Without pupil dilation · 848 x 848 pixels · 45 degree fundus photograph · NIDEK AFC-230 fundus camera · fundus photo: 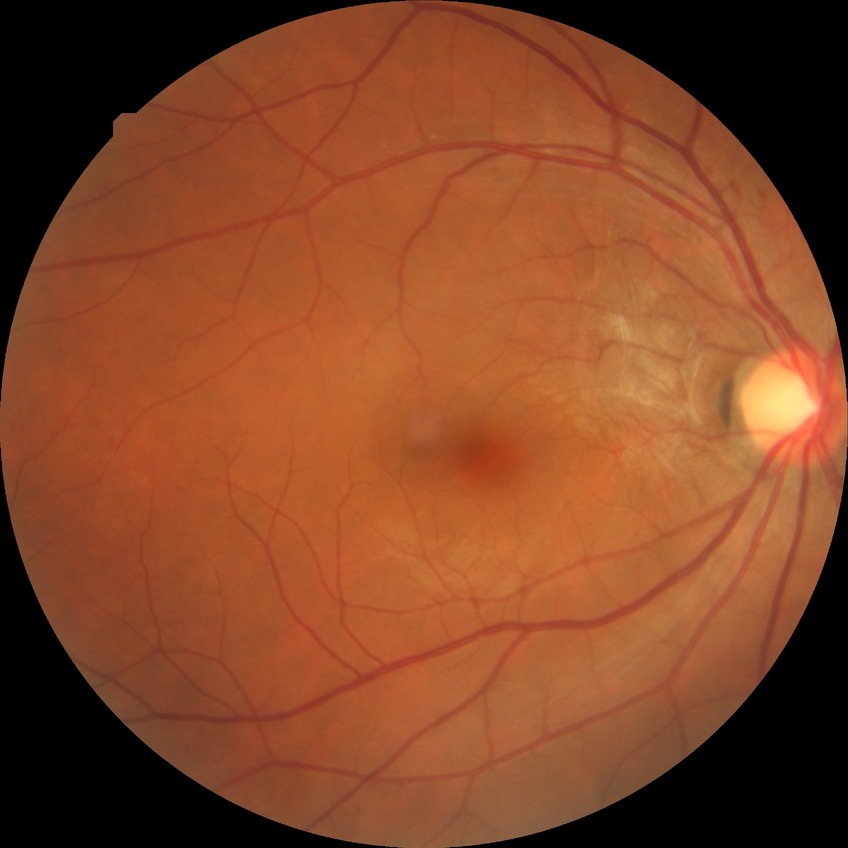

Annotations:
– DR class — non-proliferative diabetic retinopathy
– modified Davis grading — simple diabetic retinopathy